Image size 2352x1568.
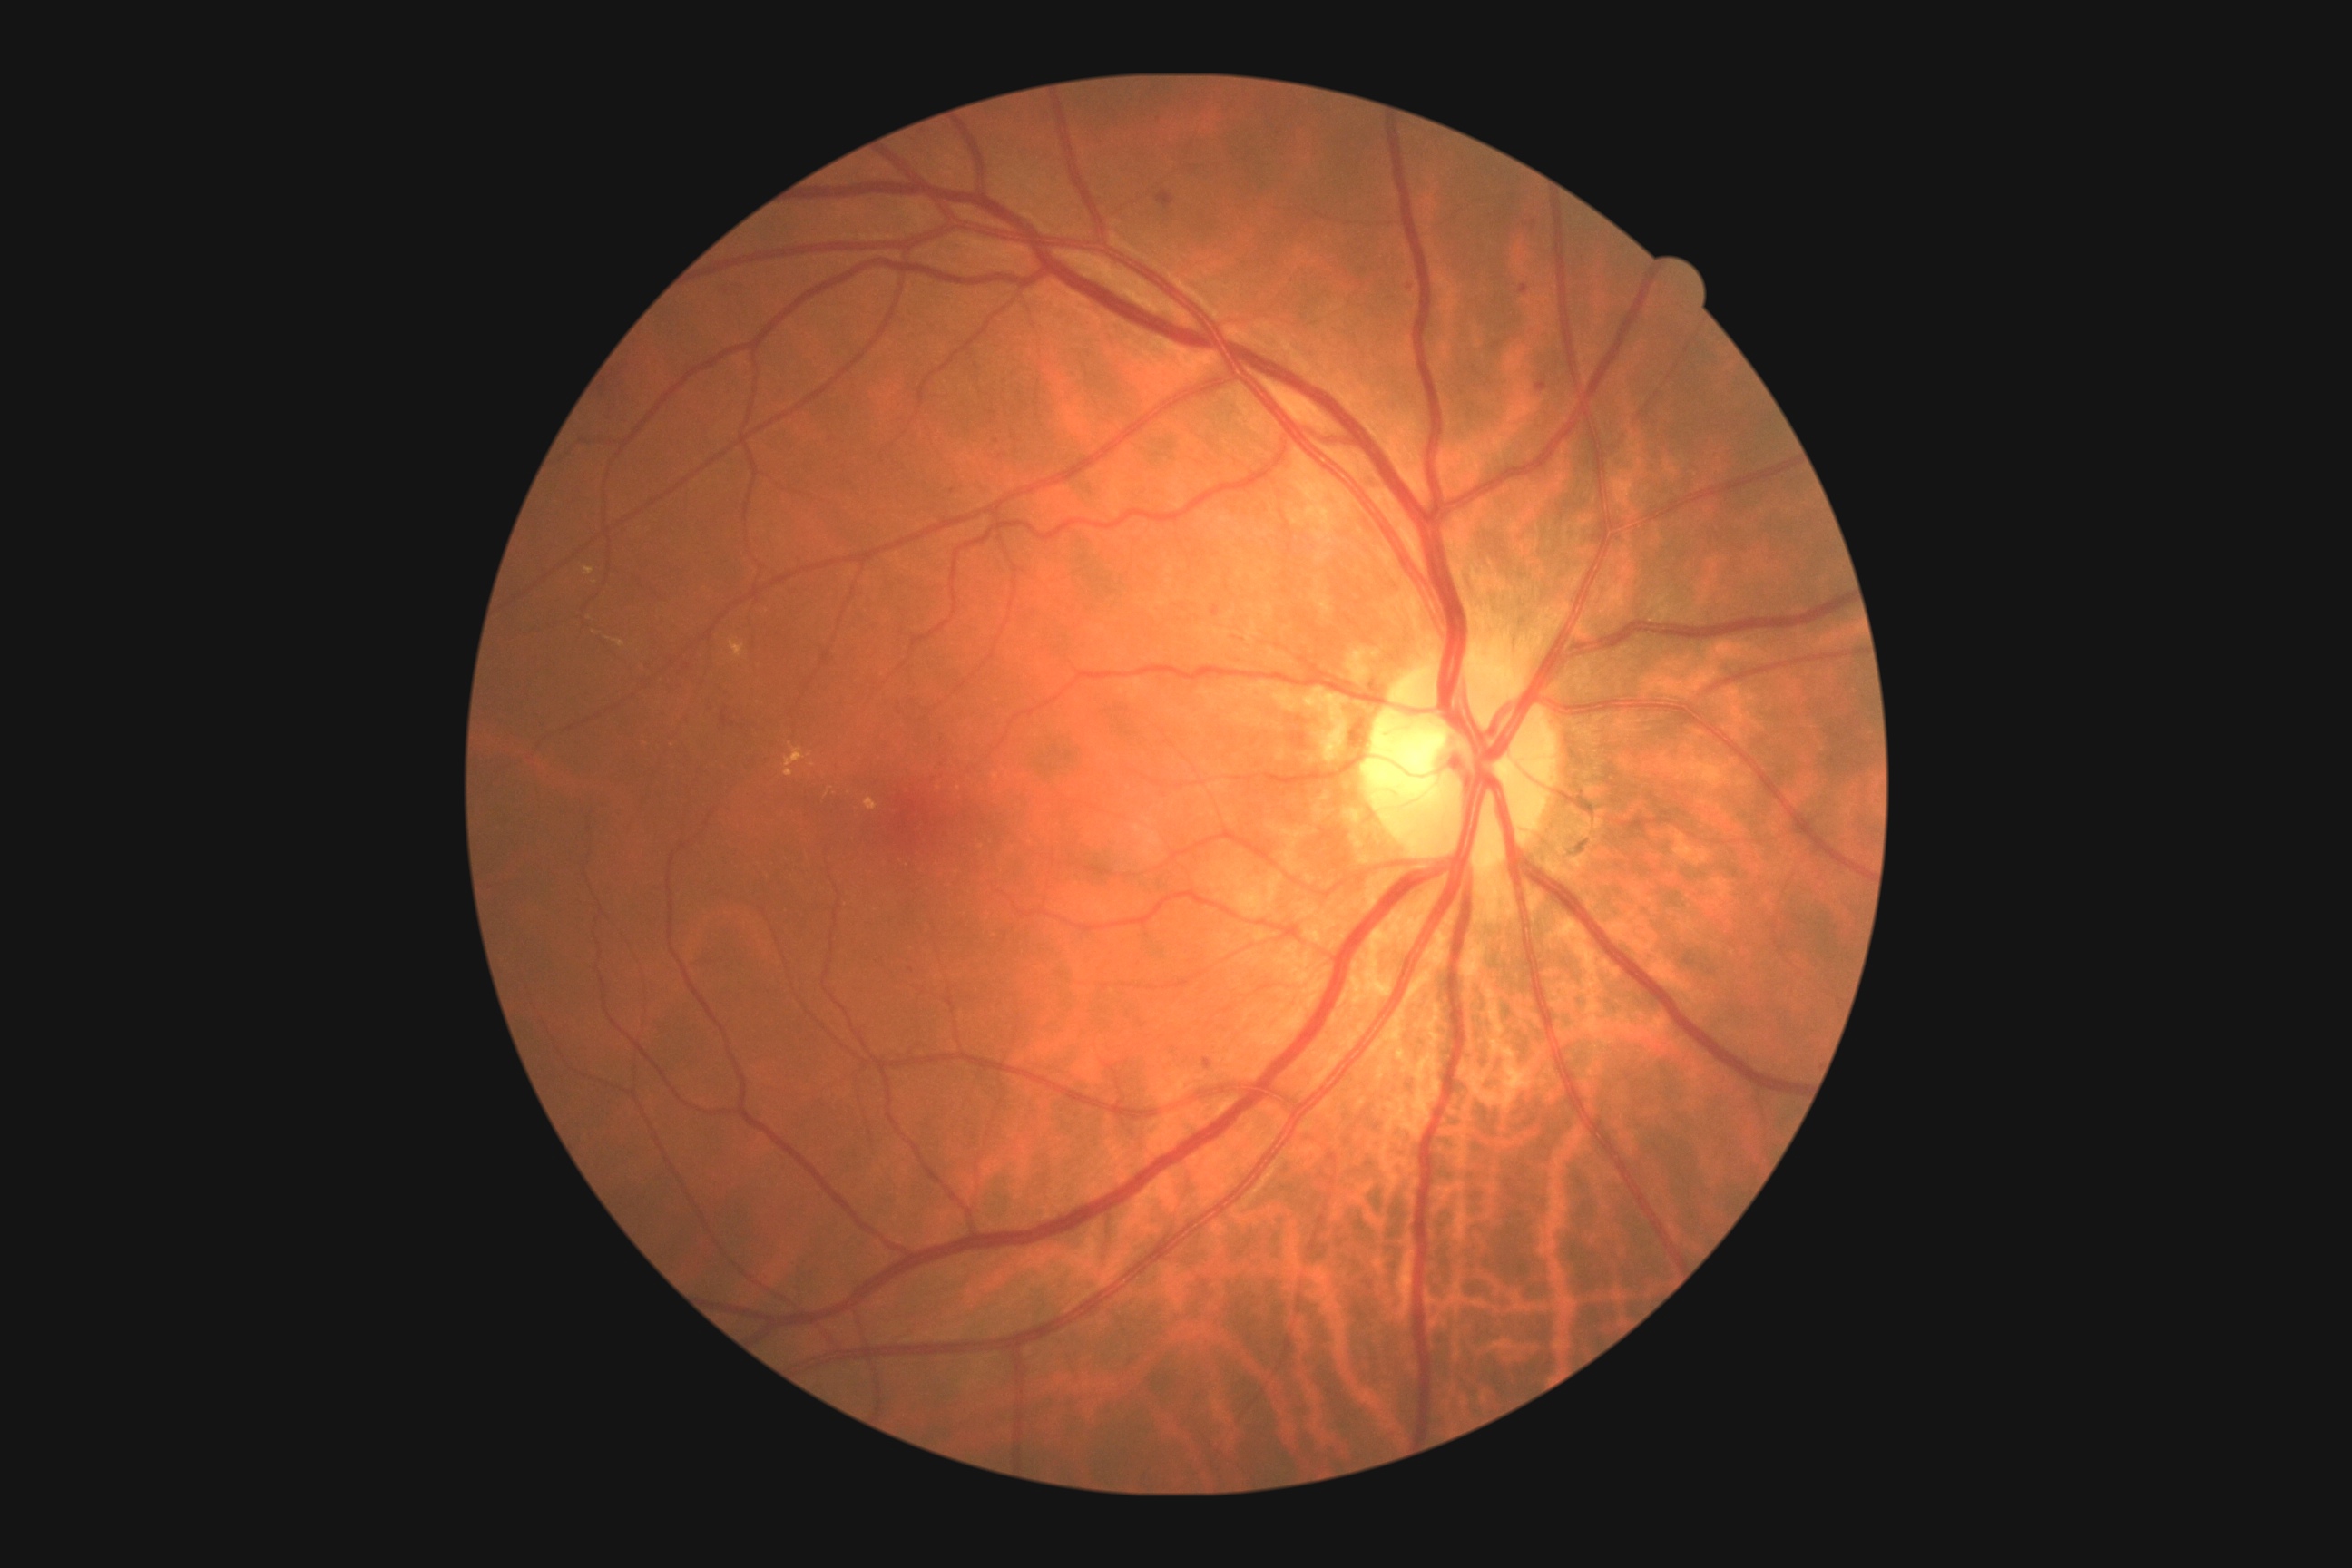

DR grade: 2 (moderate NPDR).